Wide-field fundus photograph of an infant; acquired on the Phoenix ICON:
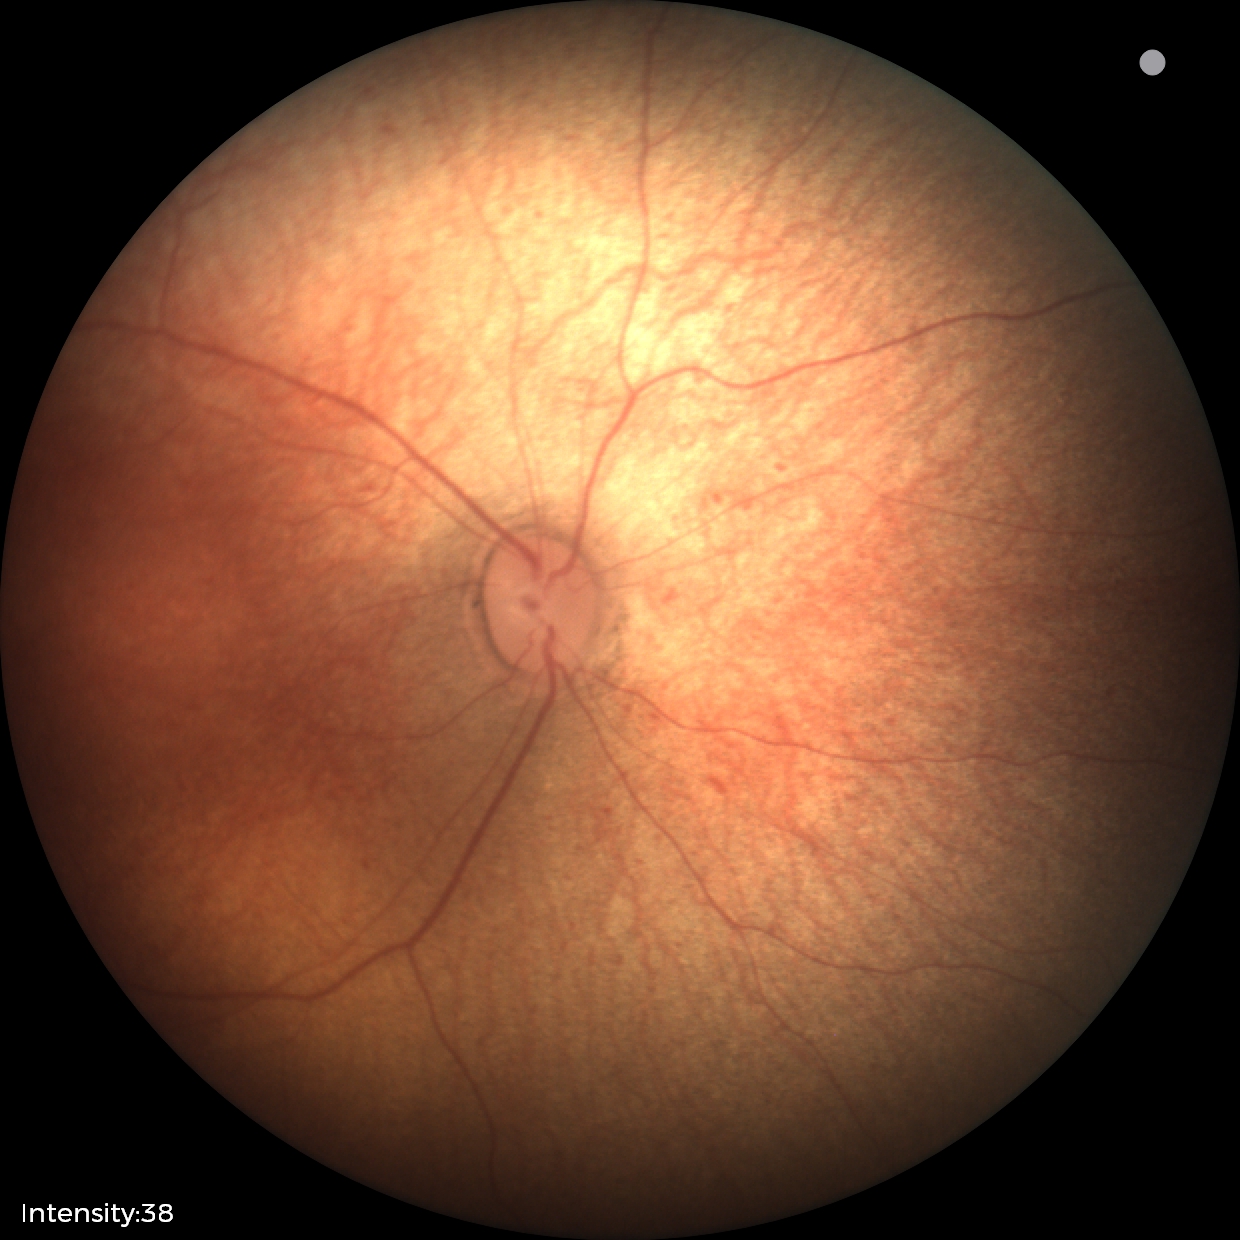 Screening: physiological retinal finding.